2361 x 1568 pixels. Fundus photo. 50° FOV. Macula-centered: 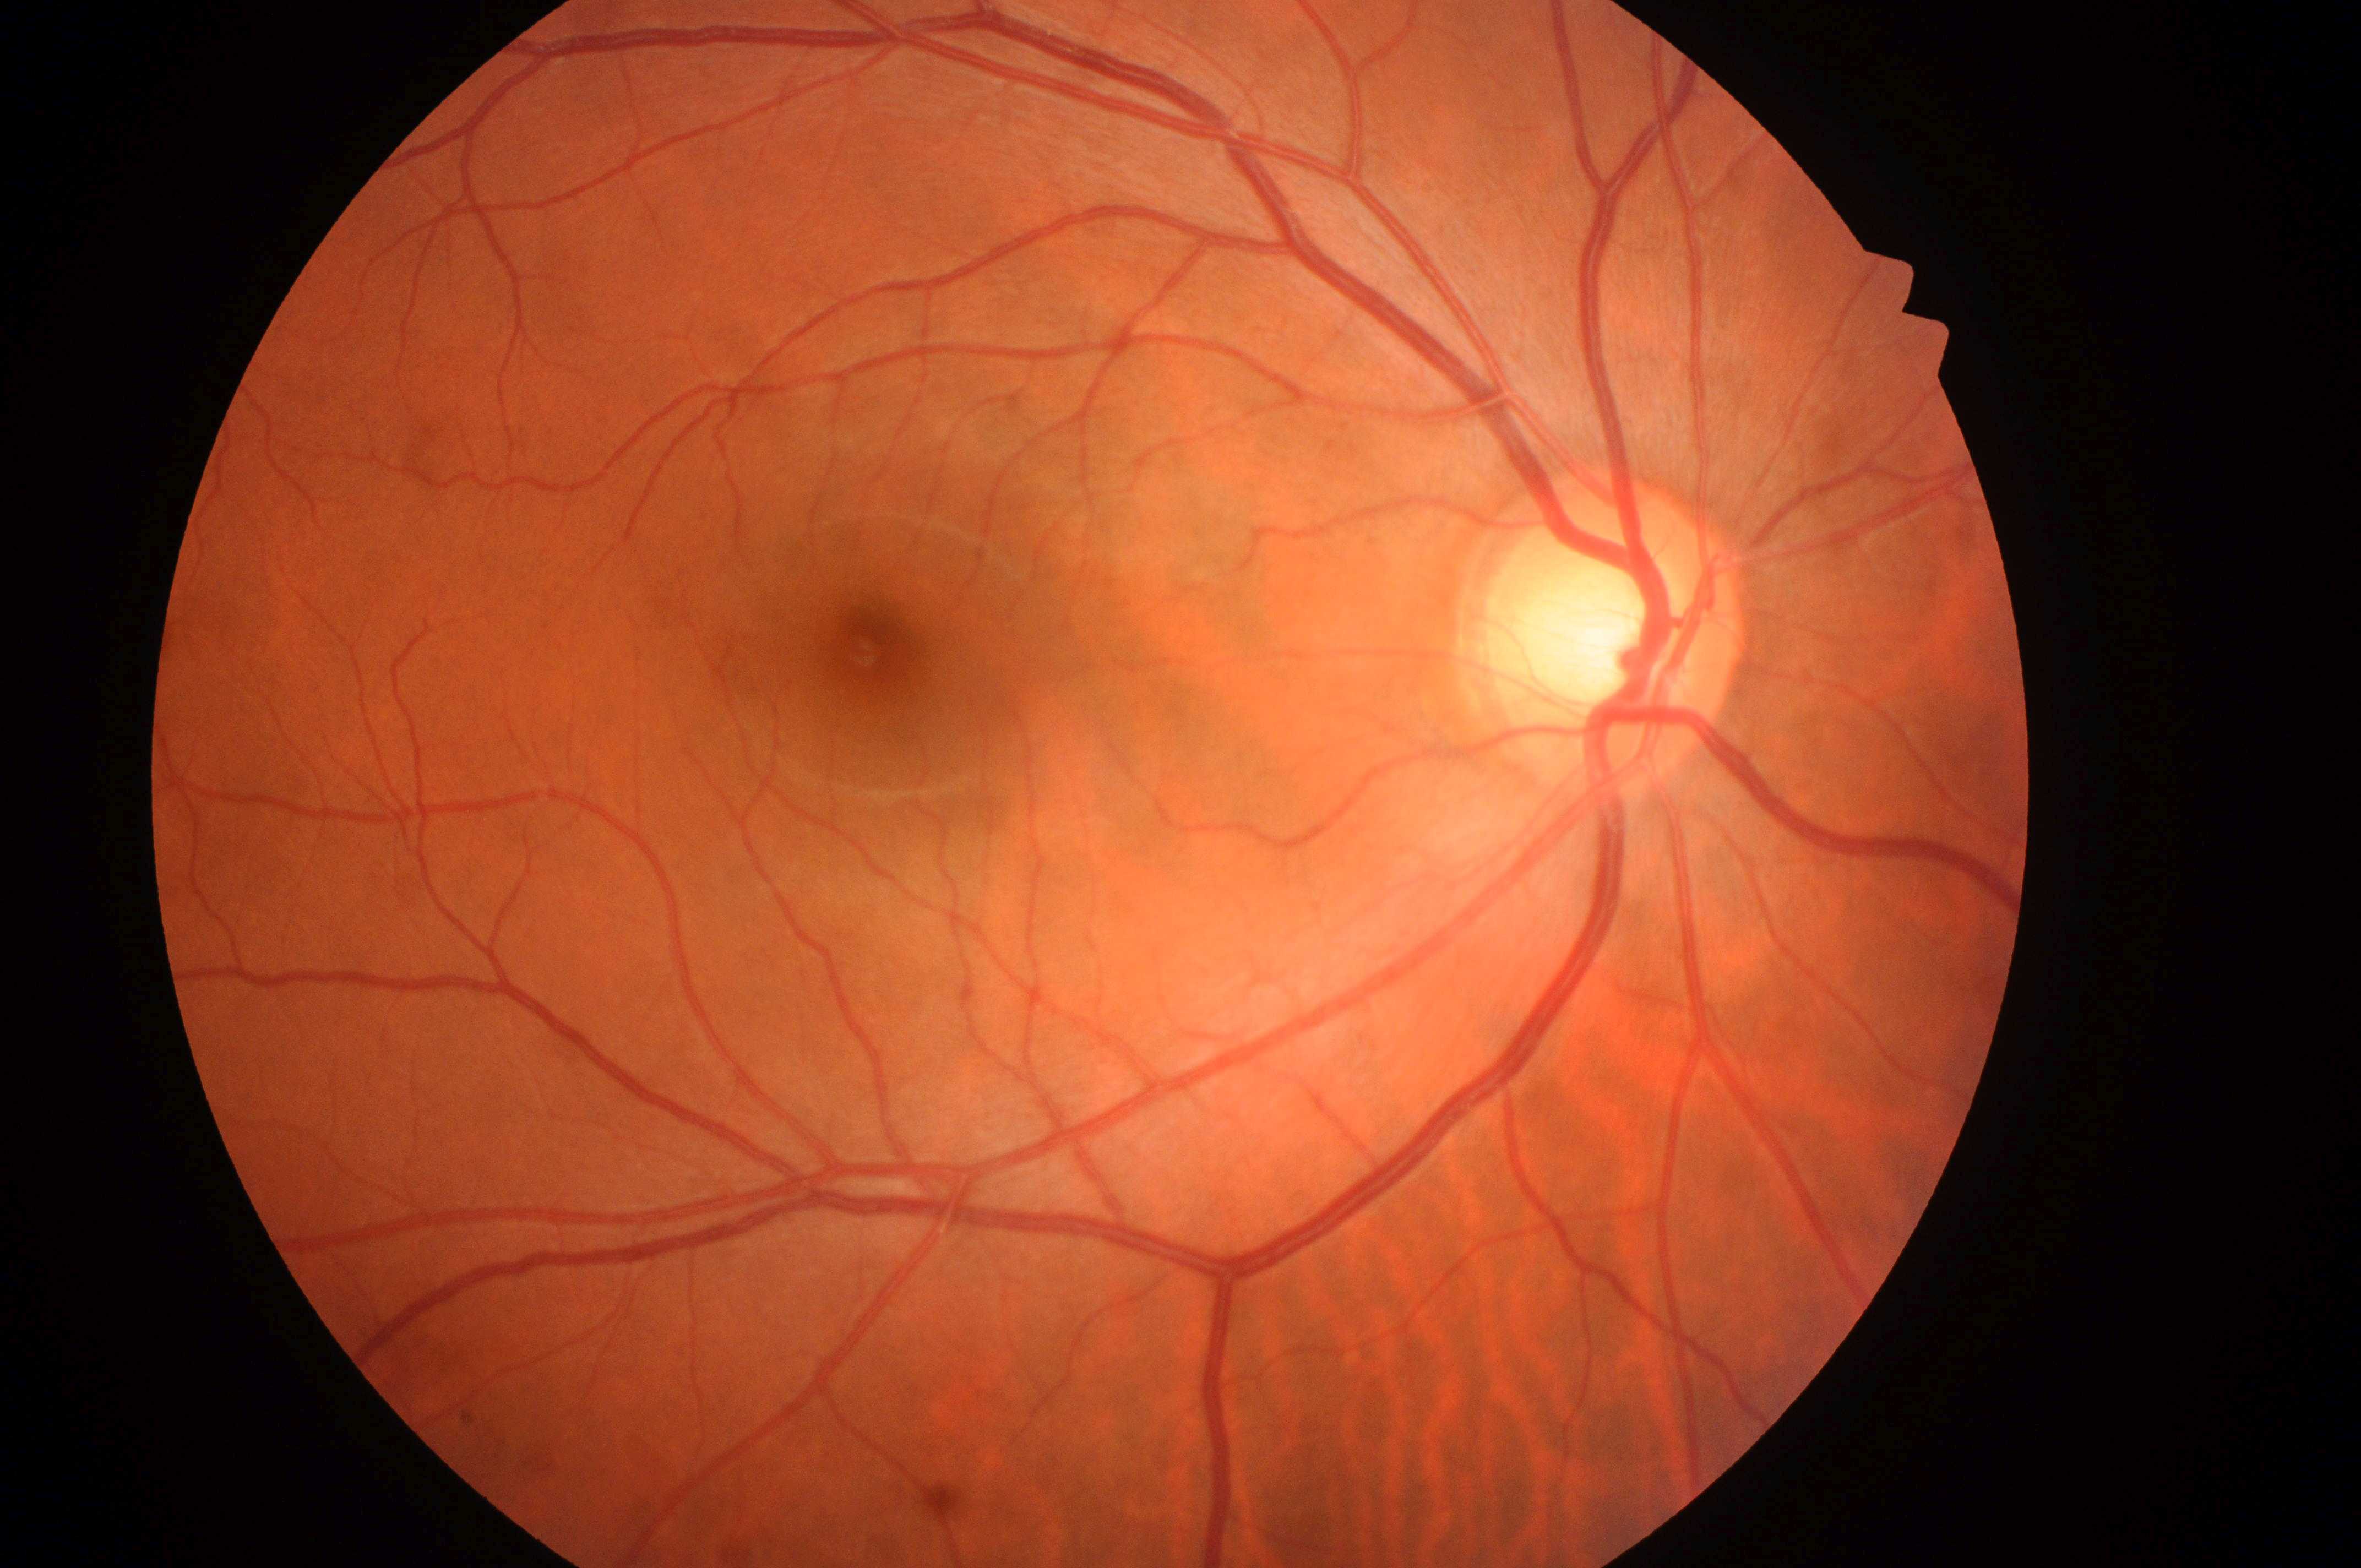 | feature | annotation |
|---|---|
| ONH | (x=1607, y=649) |
| diabetic macular edema (DME) | no risk (grade 0) |
| laterality | right |
| diabetic retinopathy (DR) | grade 0 (no apparent retinopathy) |
| foveal center | (x=871, y=655) |